Image size 848x848, without pupil dilation, fundus photo, 45-degree field of view, modified Davis grading:
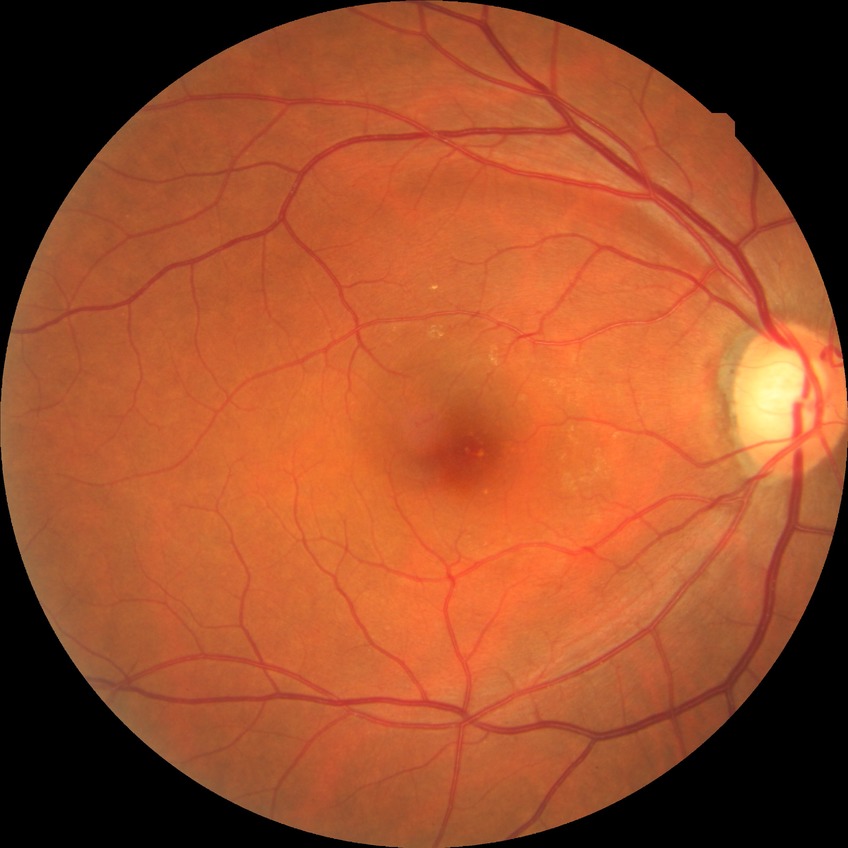 Diabetic retinopathy (DR) is simple diabetic retinopathy (SDR).